RetCam wide-field infant fundus image. 130° field of view (Clarity RetCam 3): 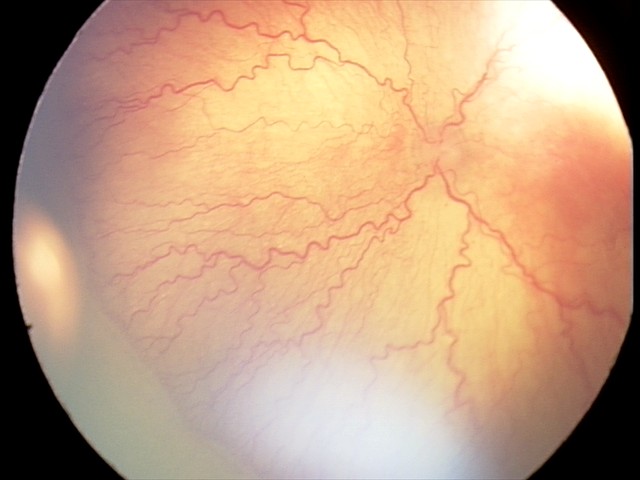
Plus disease present.
Screening series with aggressive retinopathy of prematurity.